Camera: NIDEK AFC-230, modified Davis classification, nonmydriatic, color fundus image.
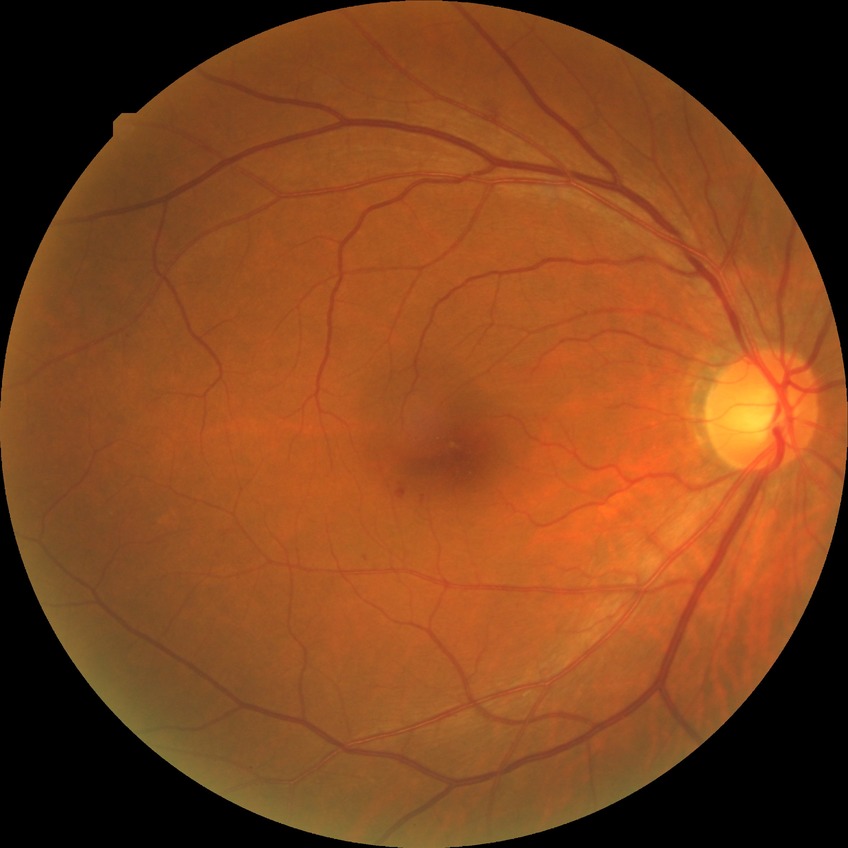 diabetic retinopathy (DR) = no diabetic retinopathy (NDR).